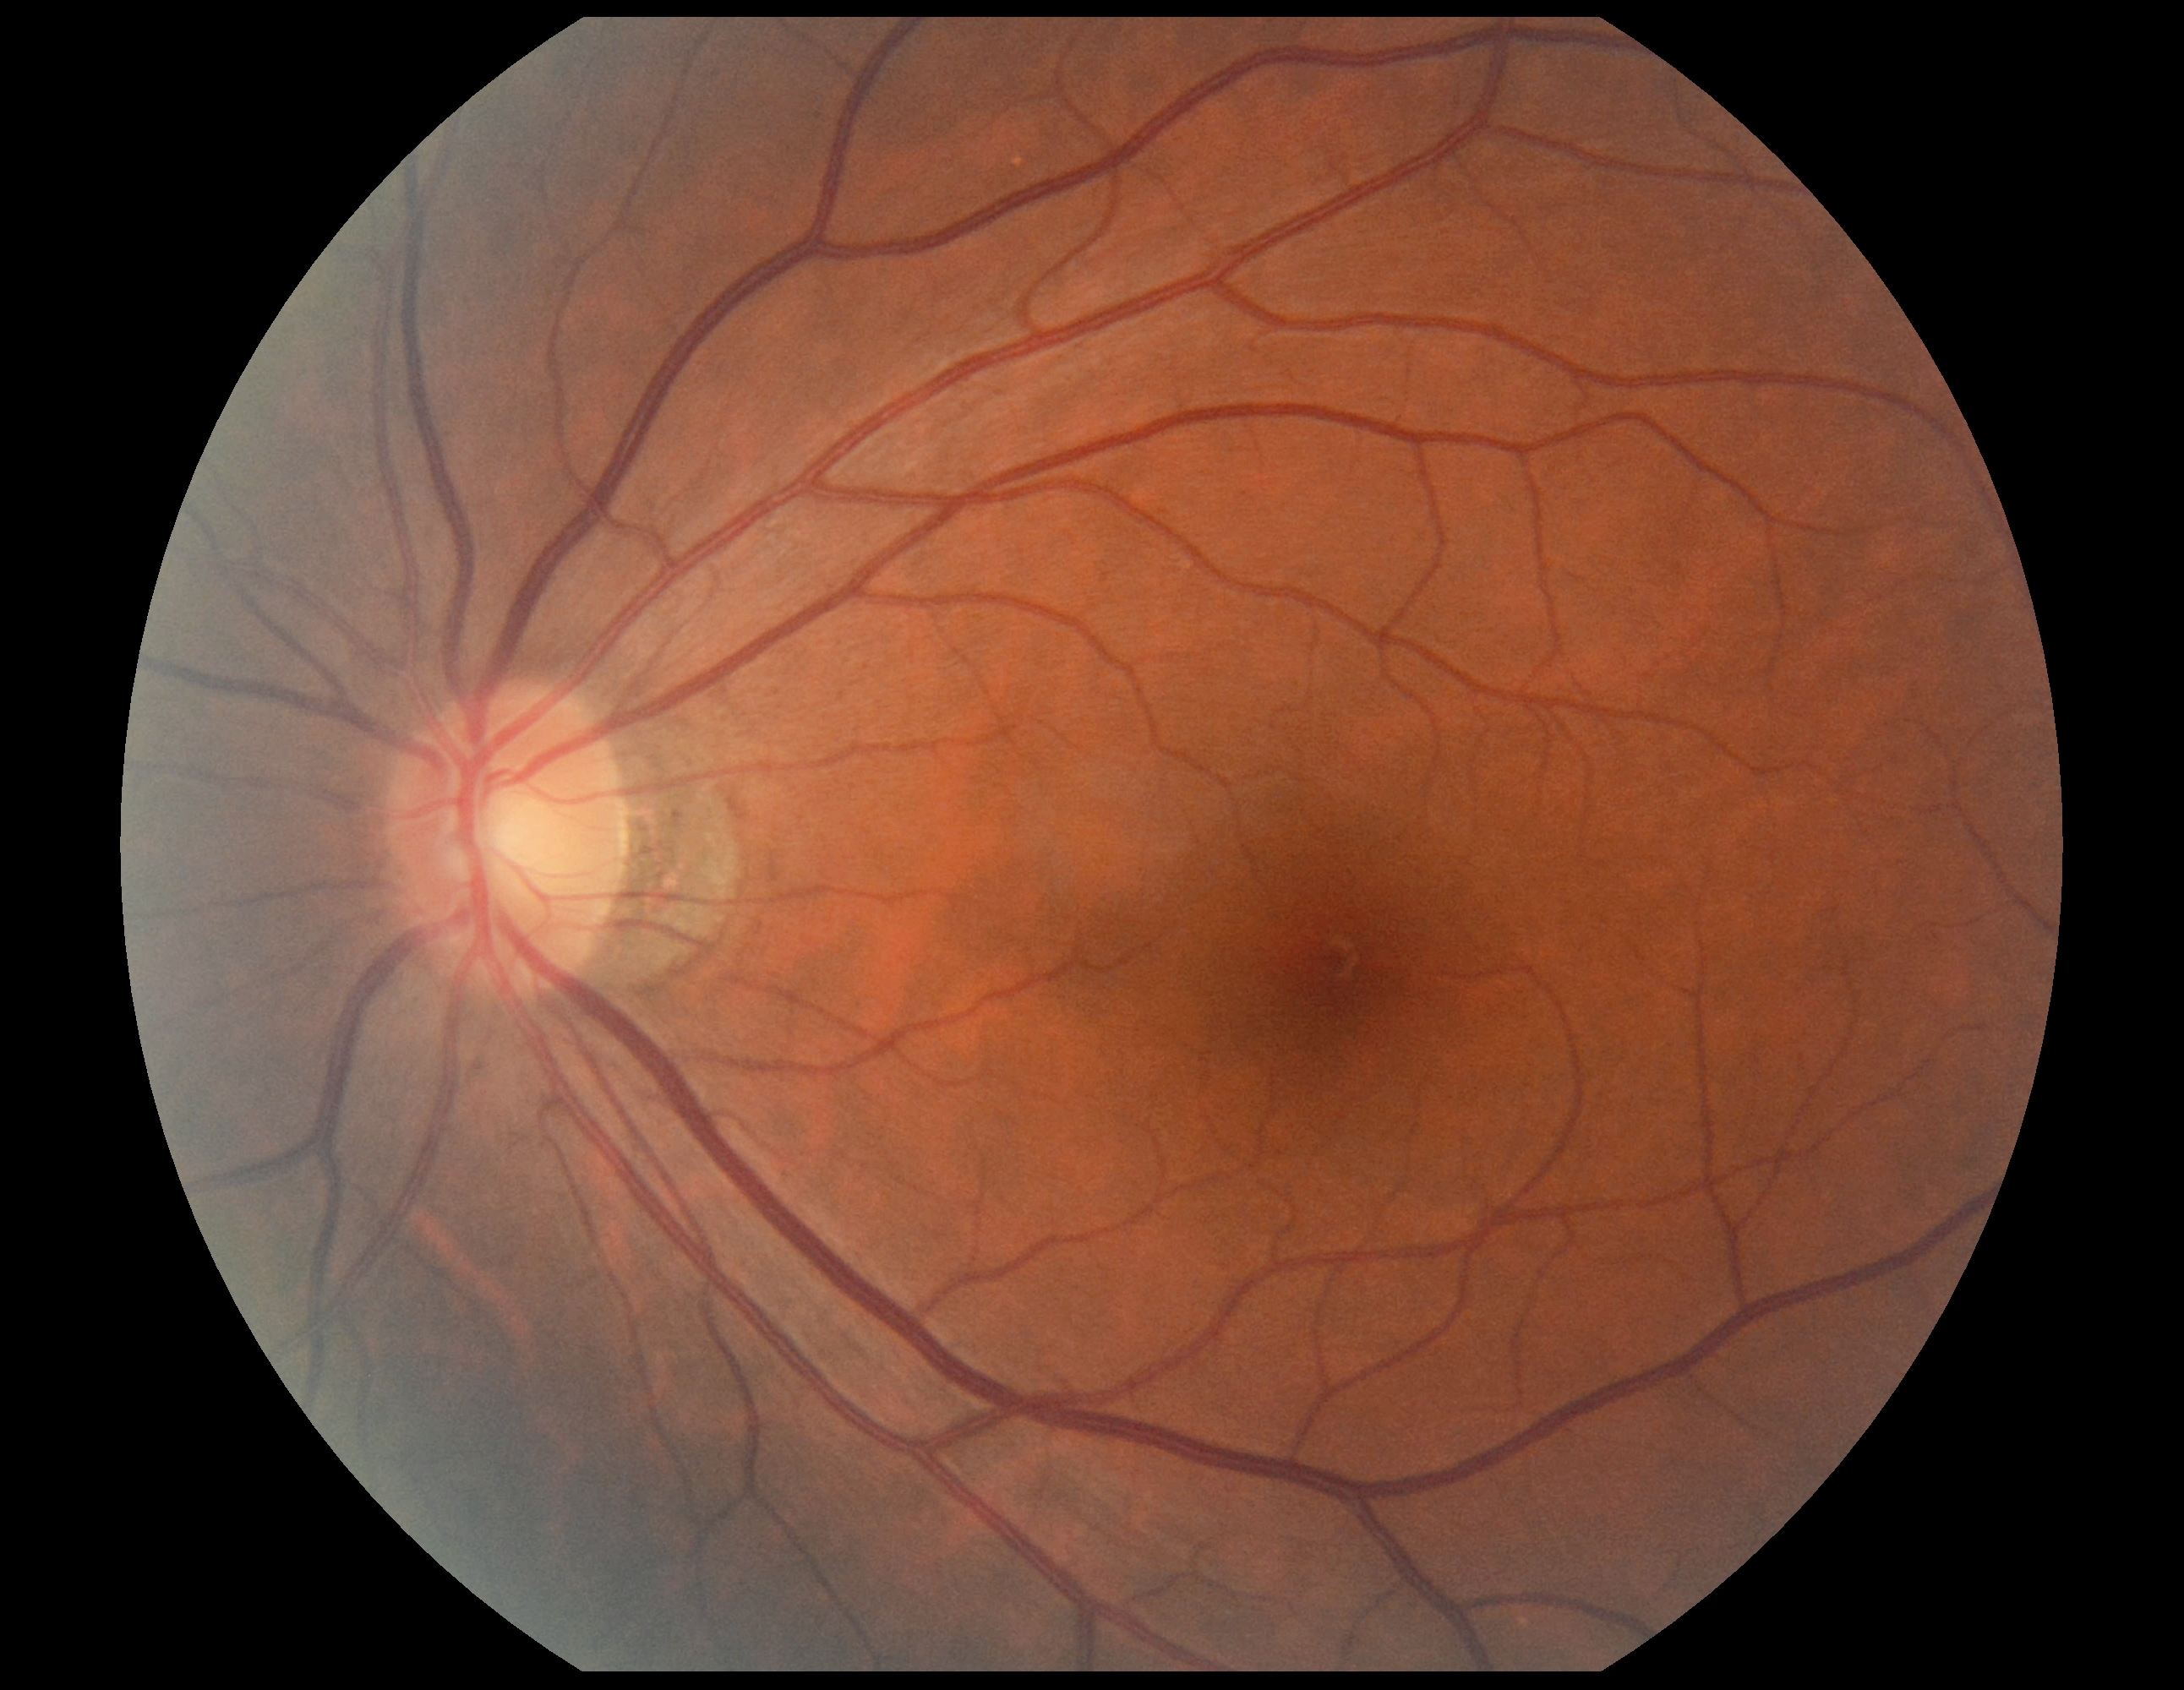
Retinopathy grade is 0.